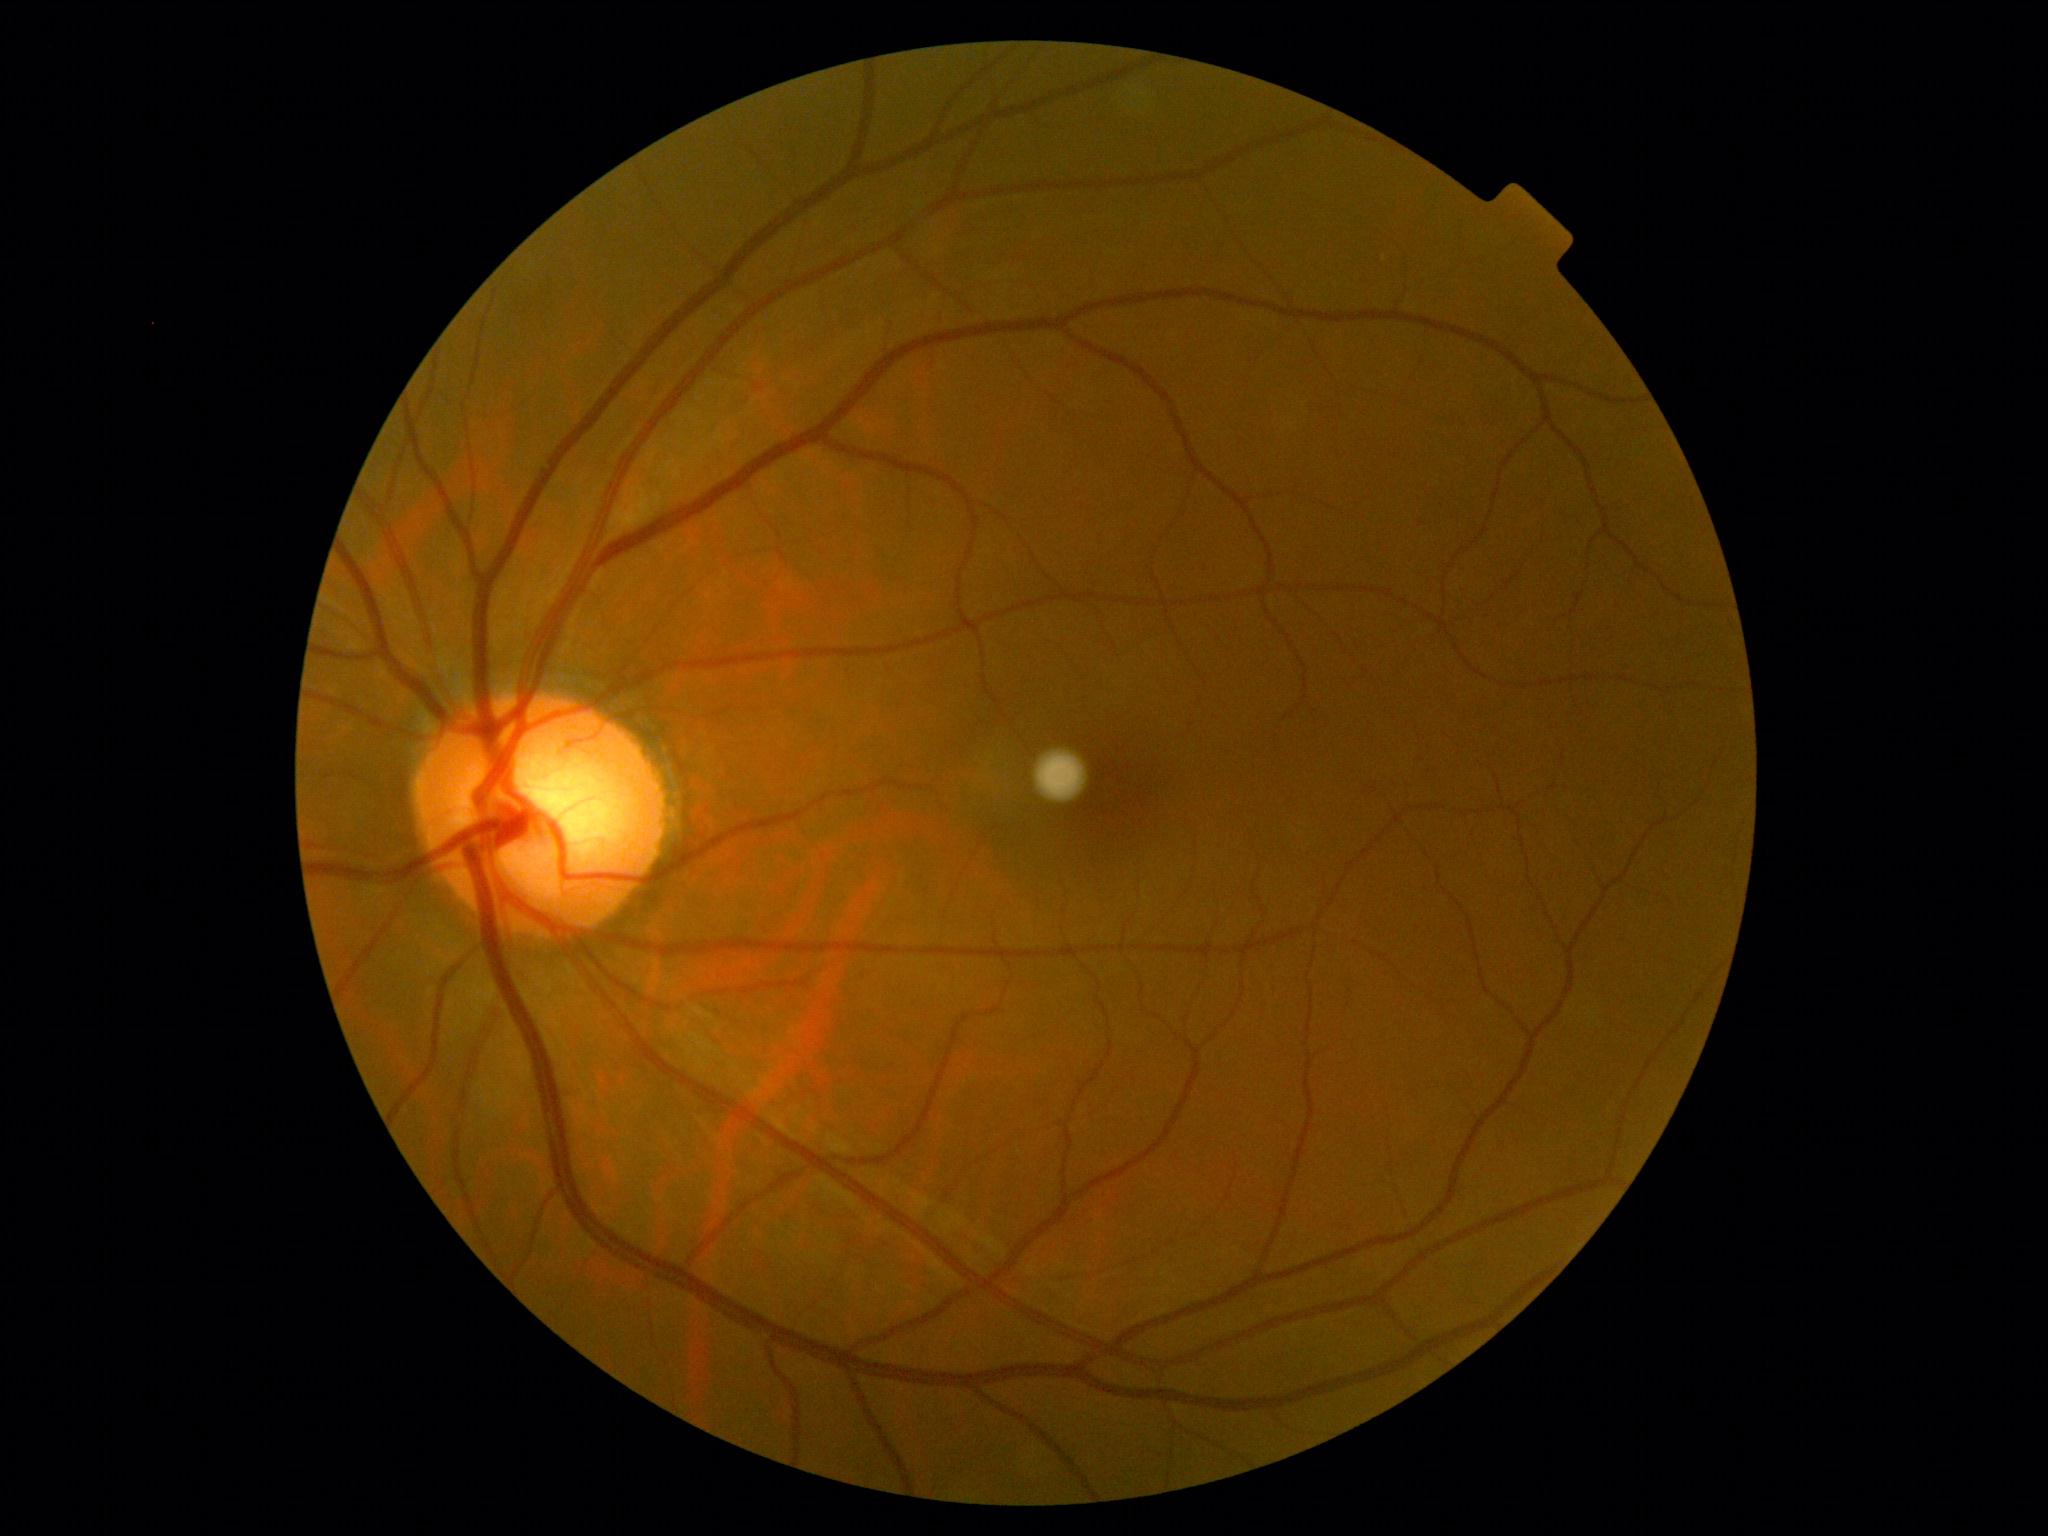
retinopathy grade=no apparent retinopathy (0) — no visible signs of diabetic retinopathy.